Macula-centered: 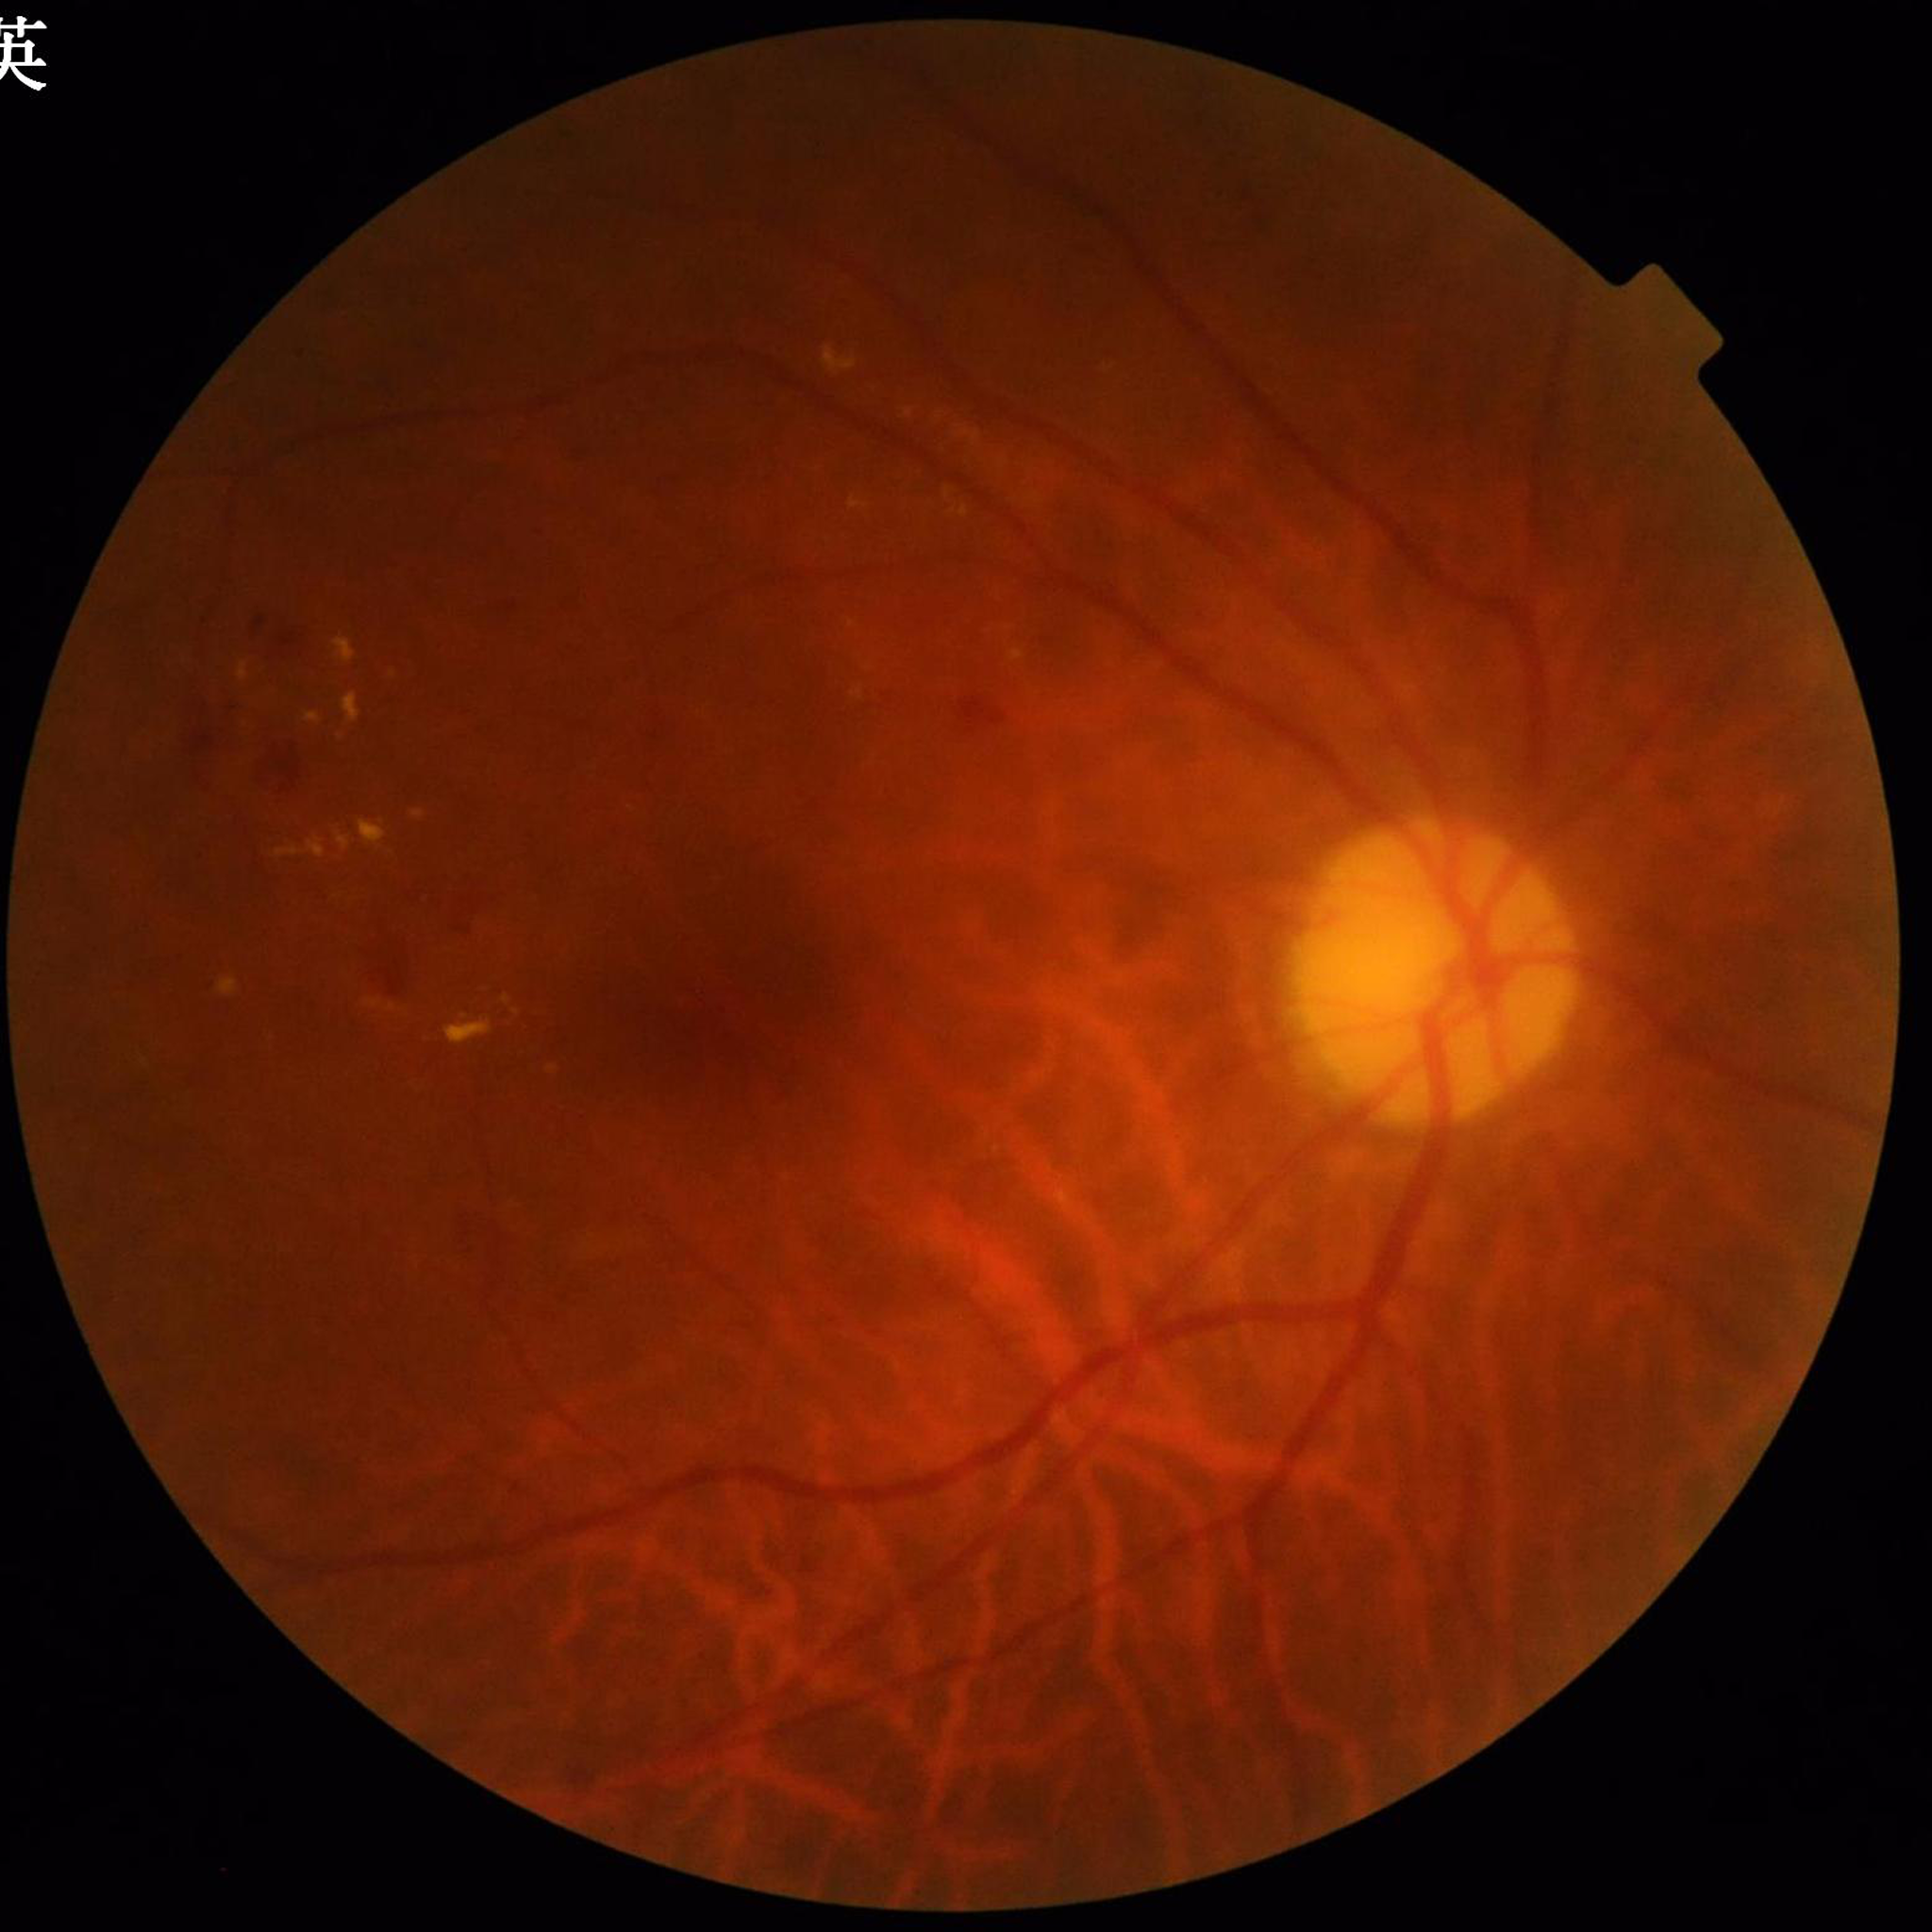 Photo quality: no quality issues identified. Diagnosed with diabetic retinopathy.